Retinal fundus photograph — 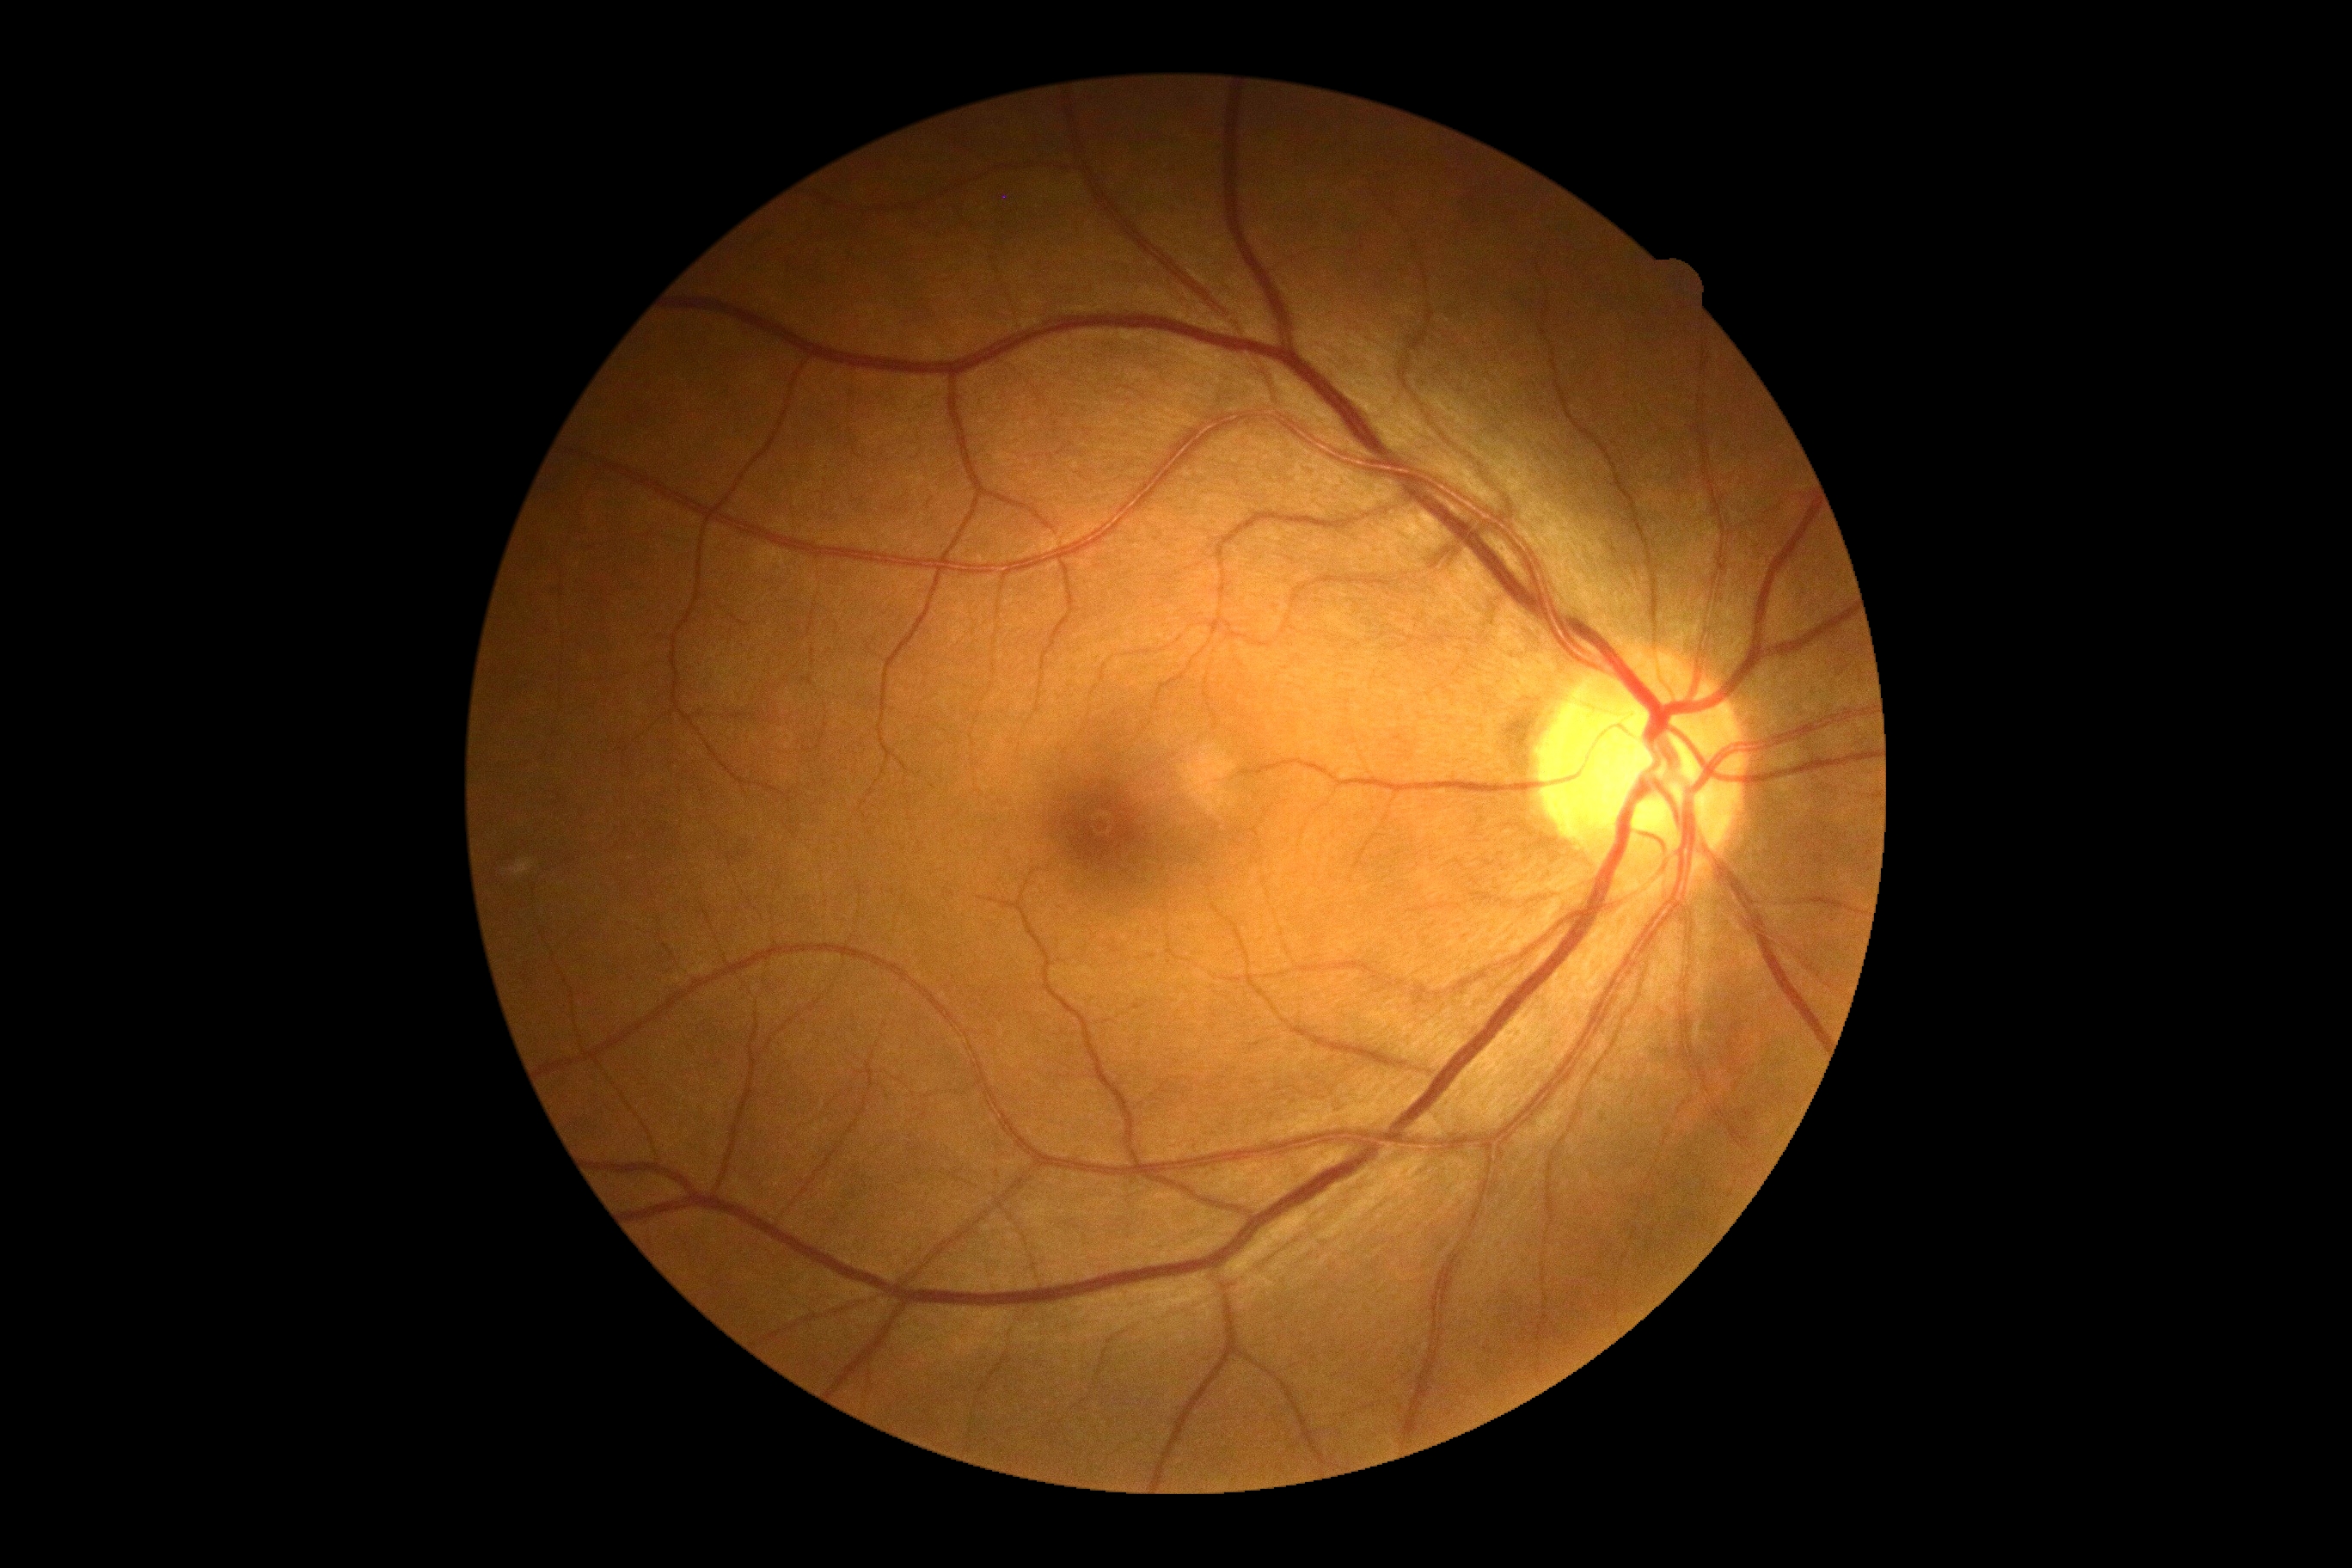

DR: 0/4.